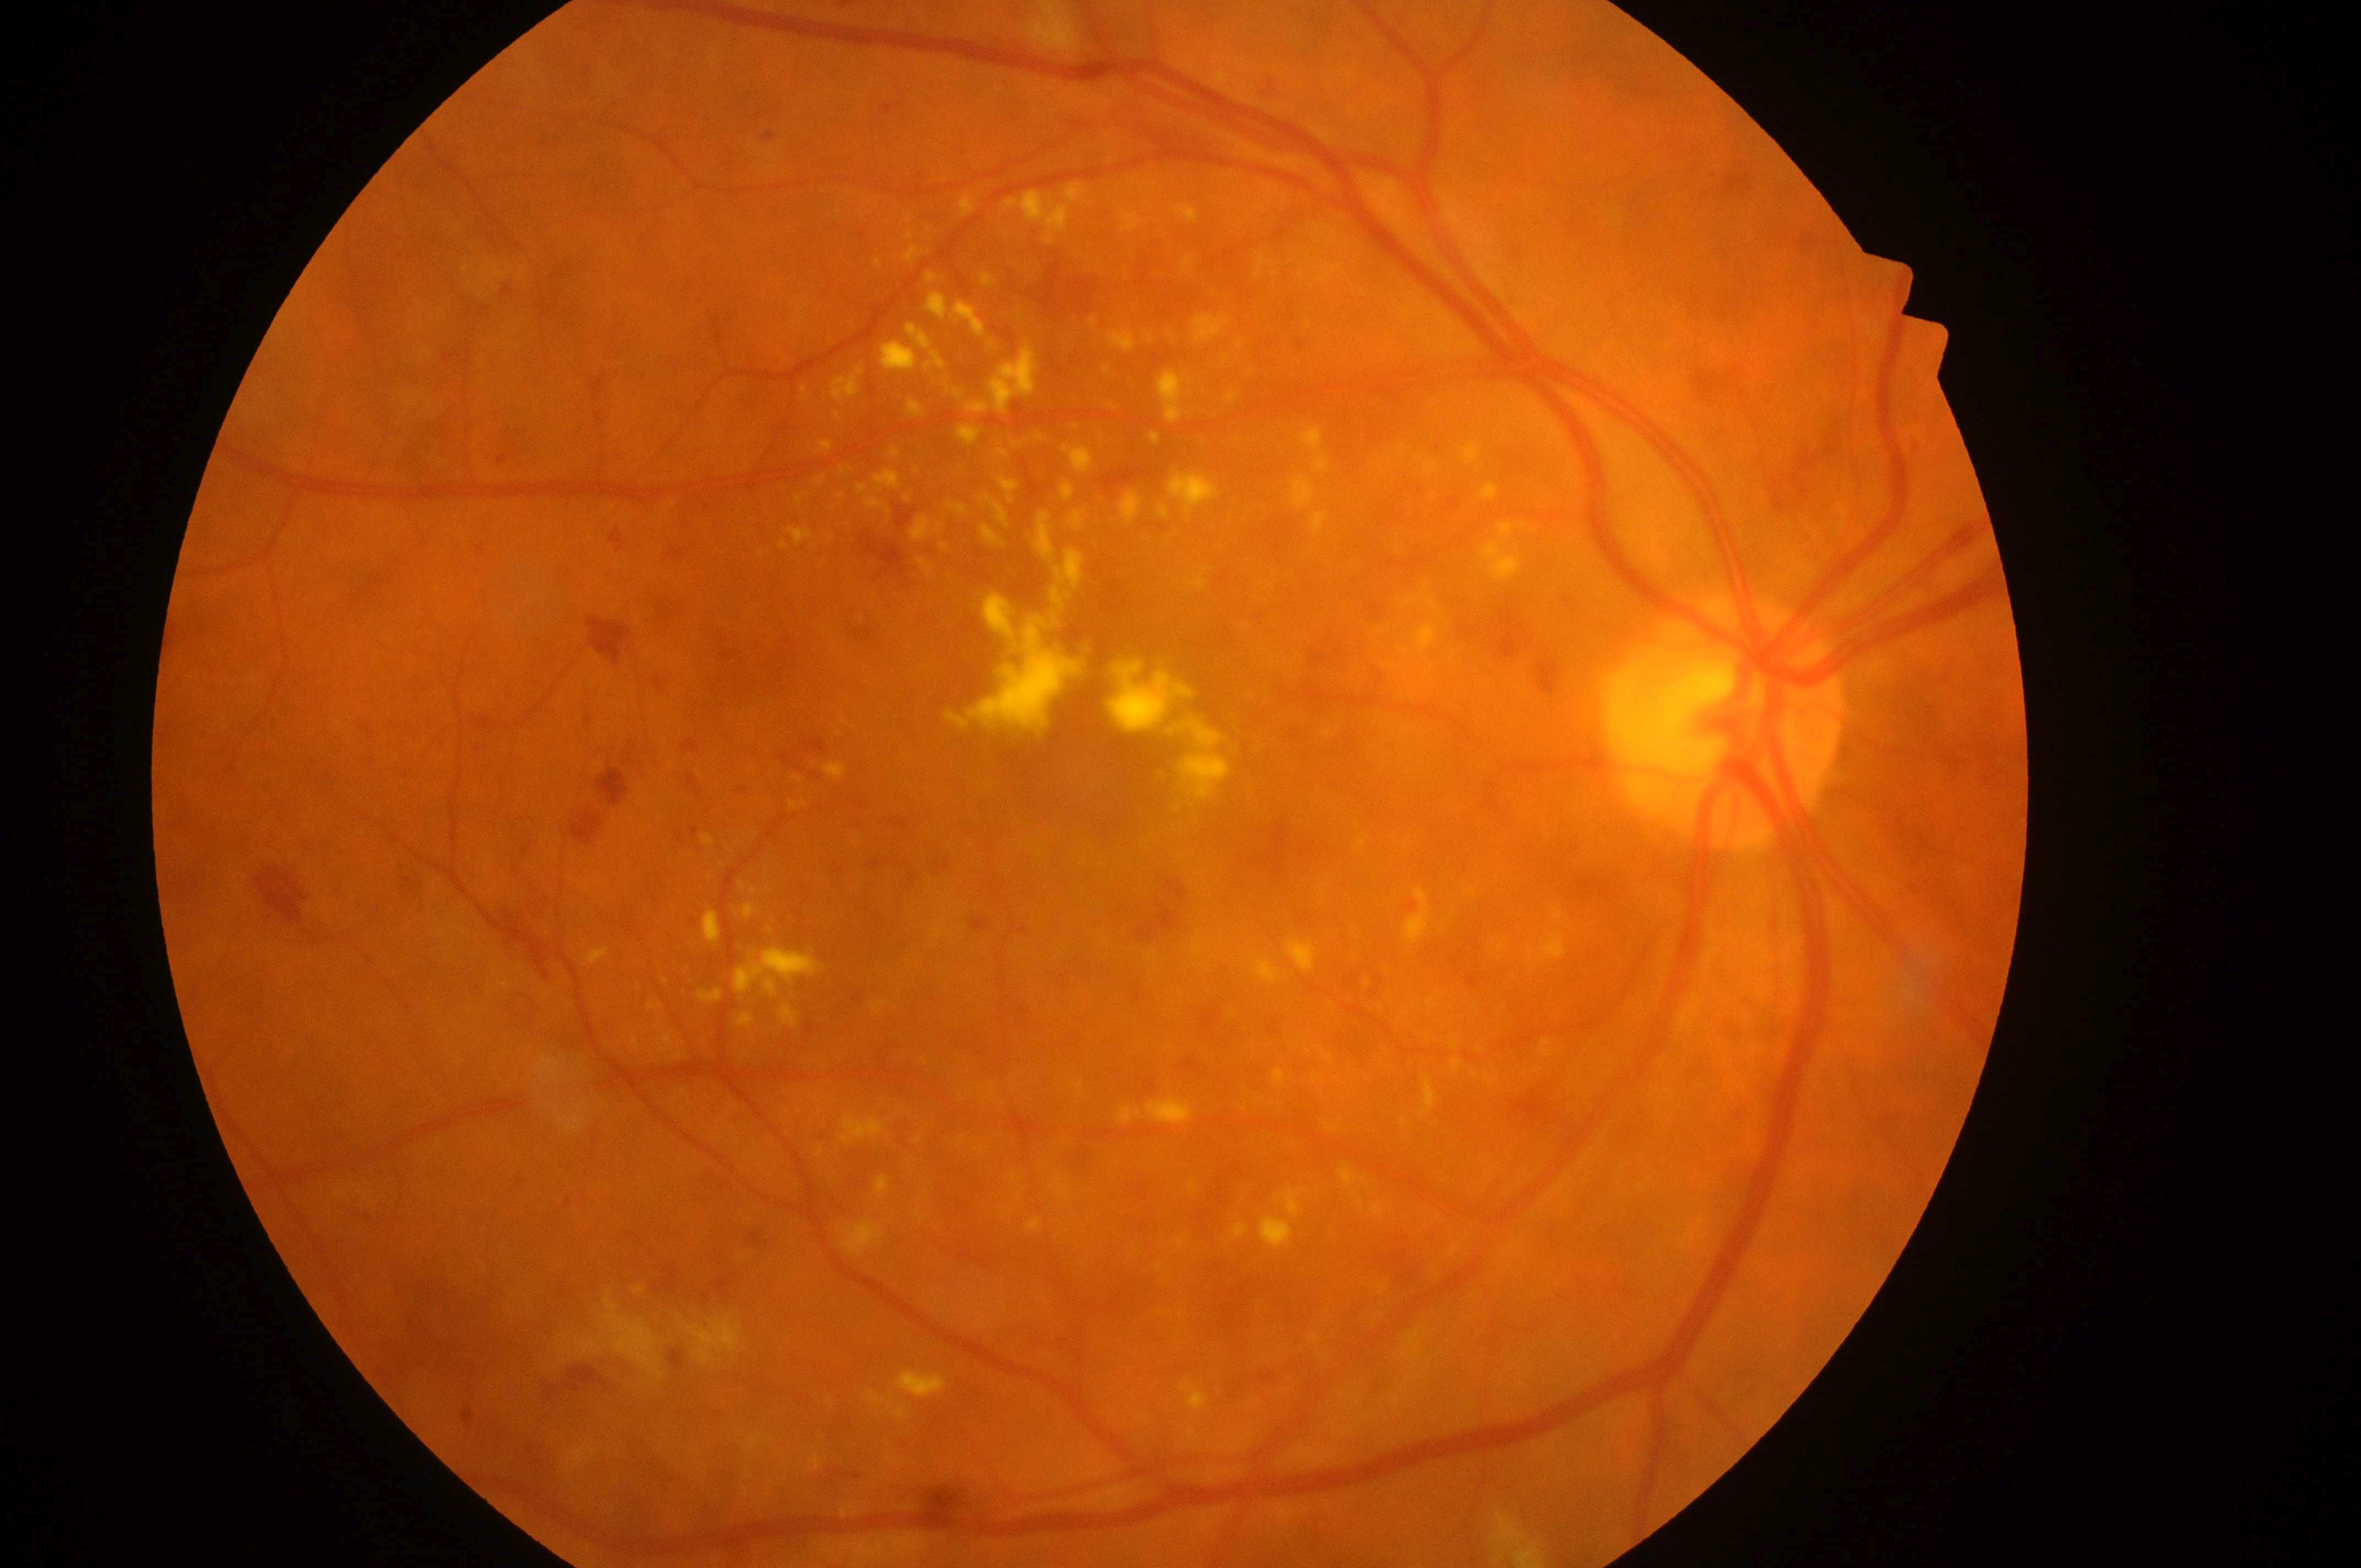 Annotations:
– DME grade: high risk (2)
– DR: severe NPDR (grade 3)
– macula center: [1101, 763]
– laterality: the right eye
– optic nerve head: [1727, 729]